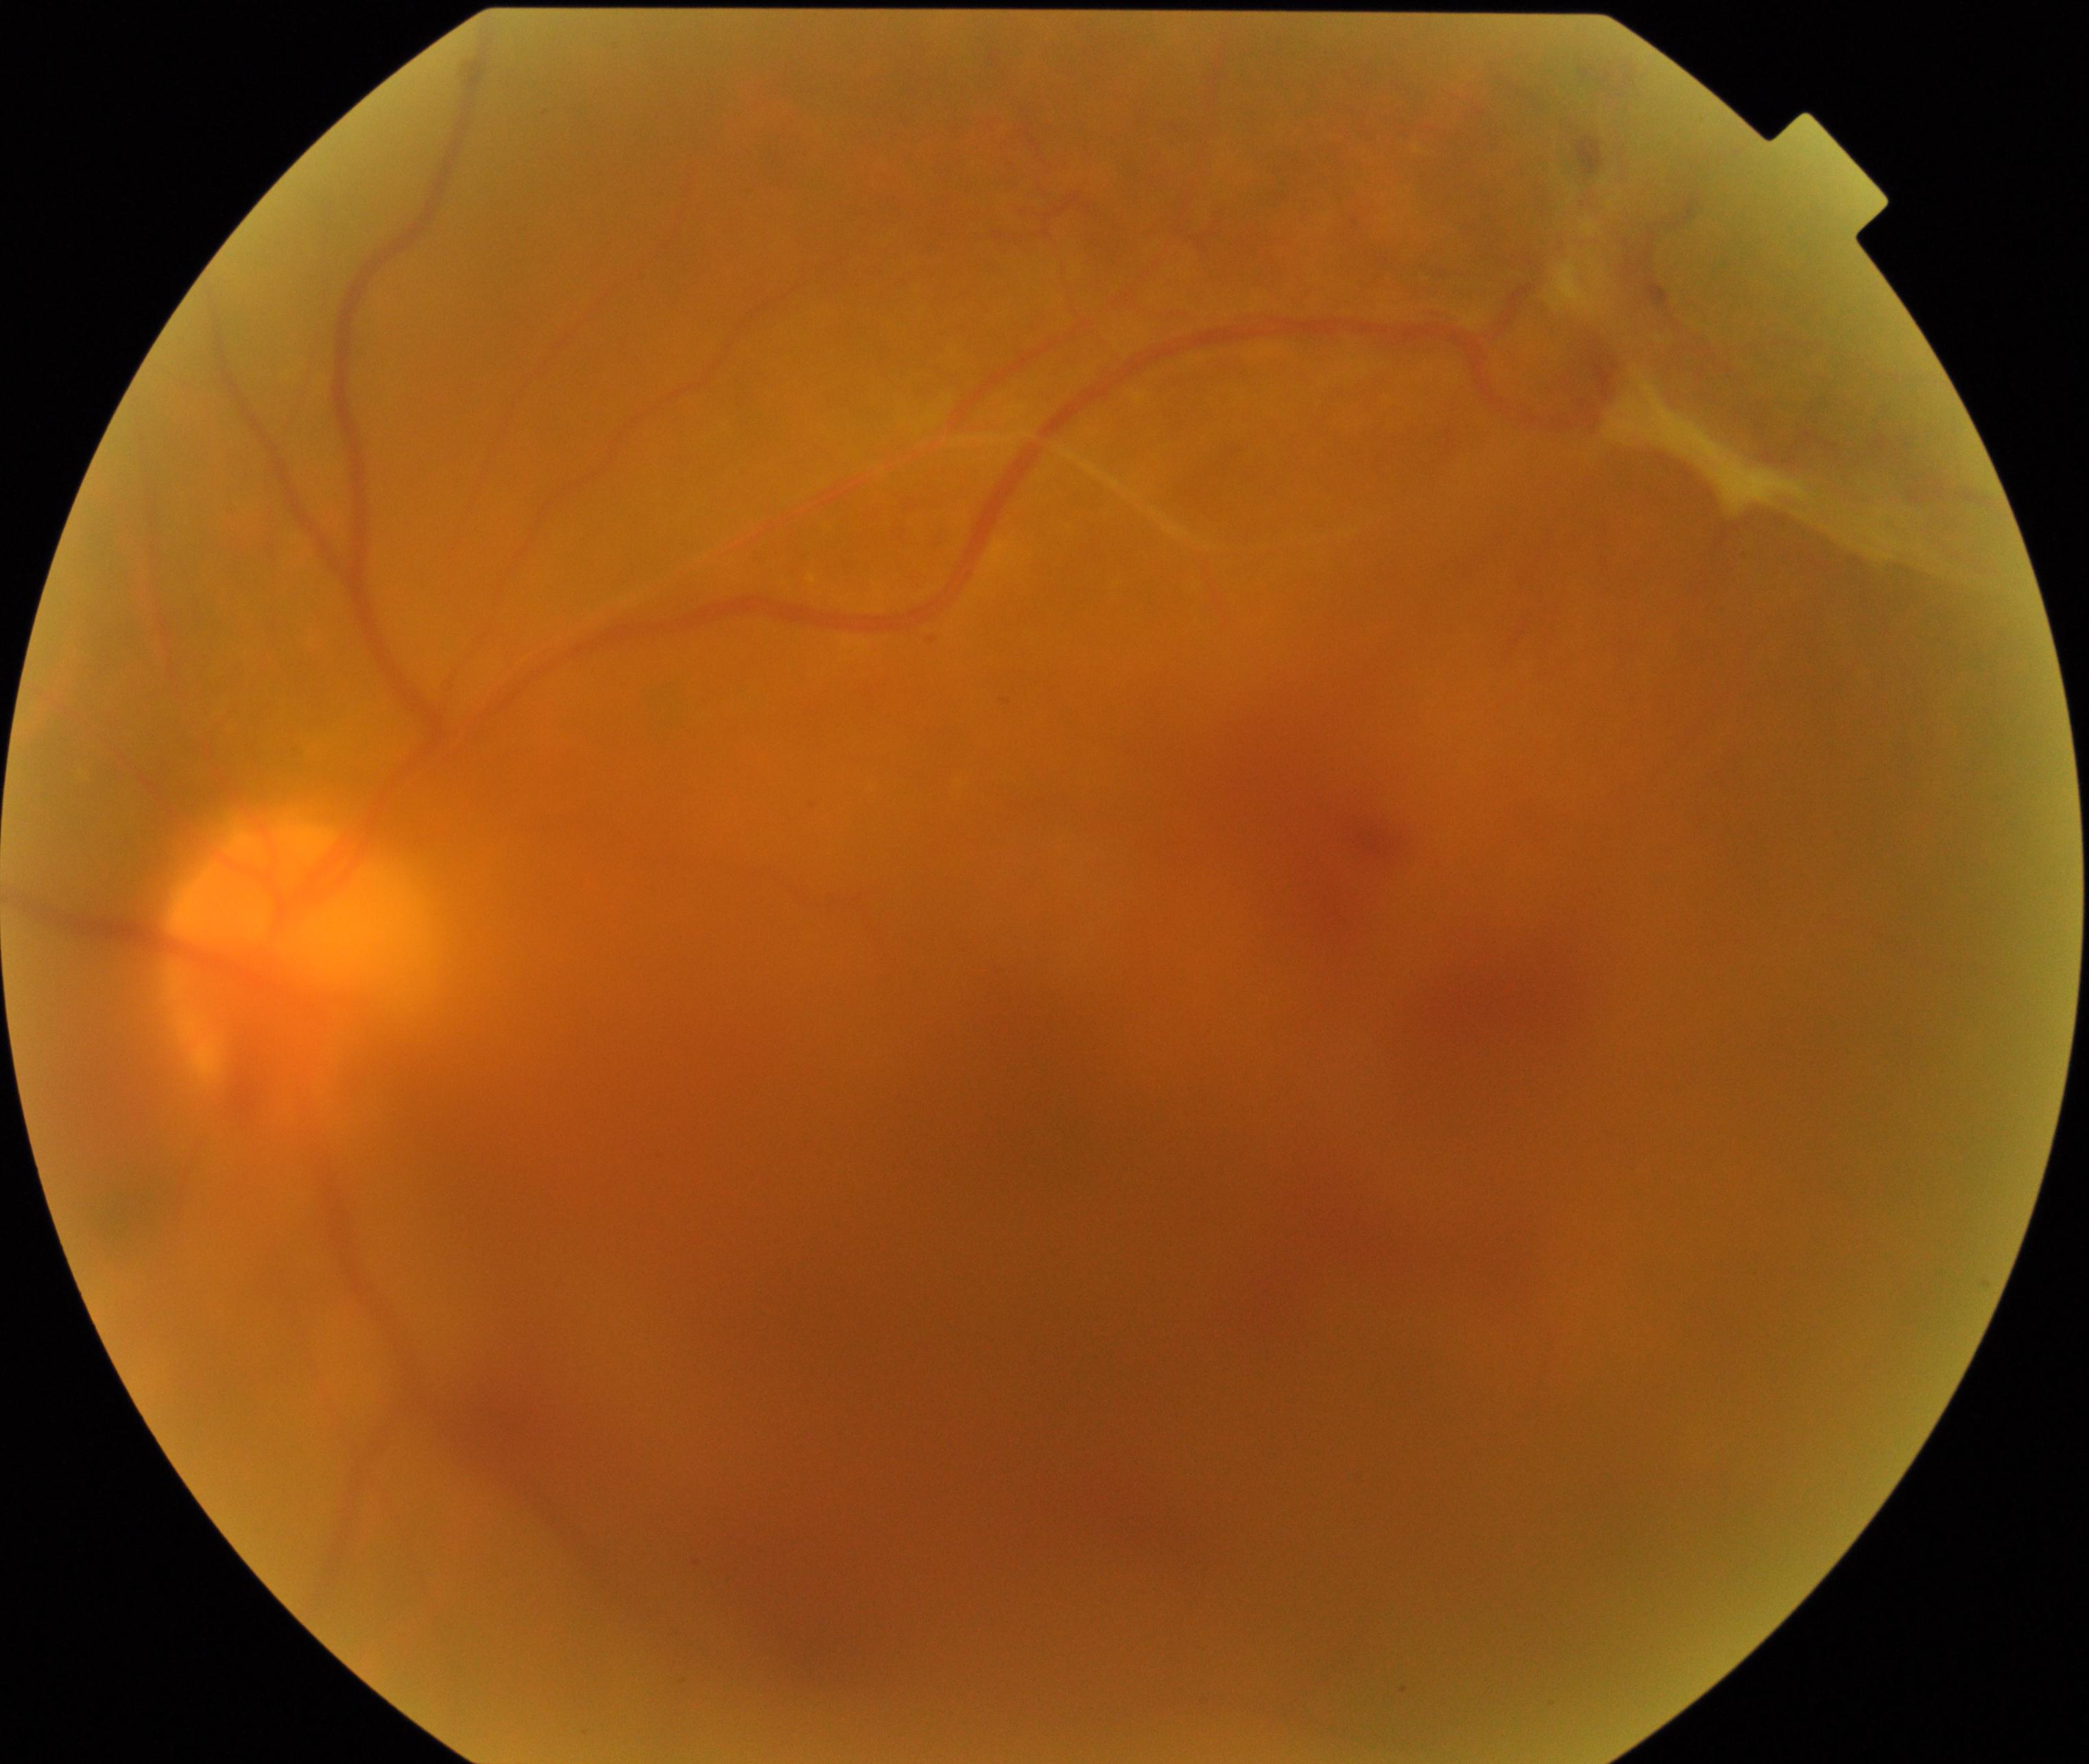
Quality: significantly degraded. Proliferative diabetic retinopathy: features suspicious.